Image size 2352x1568: 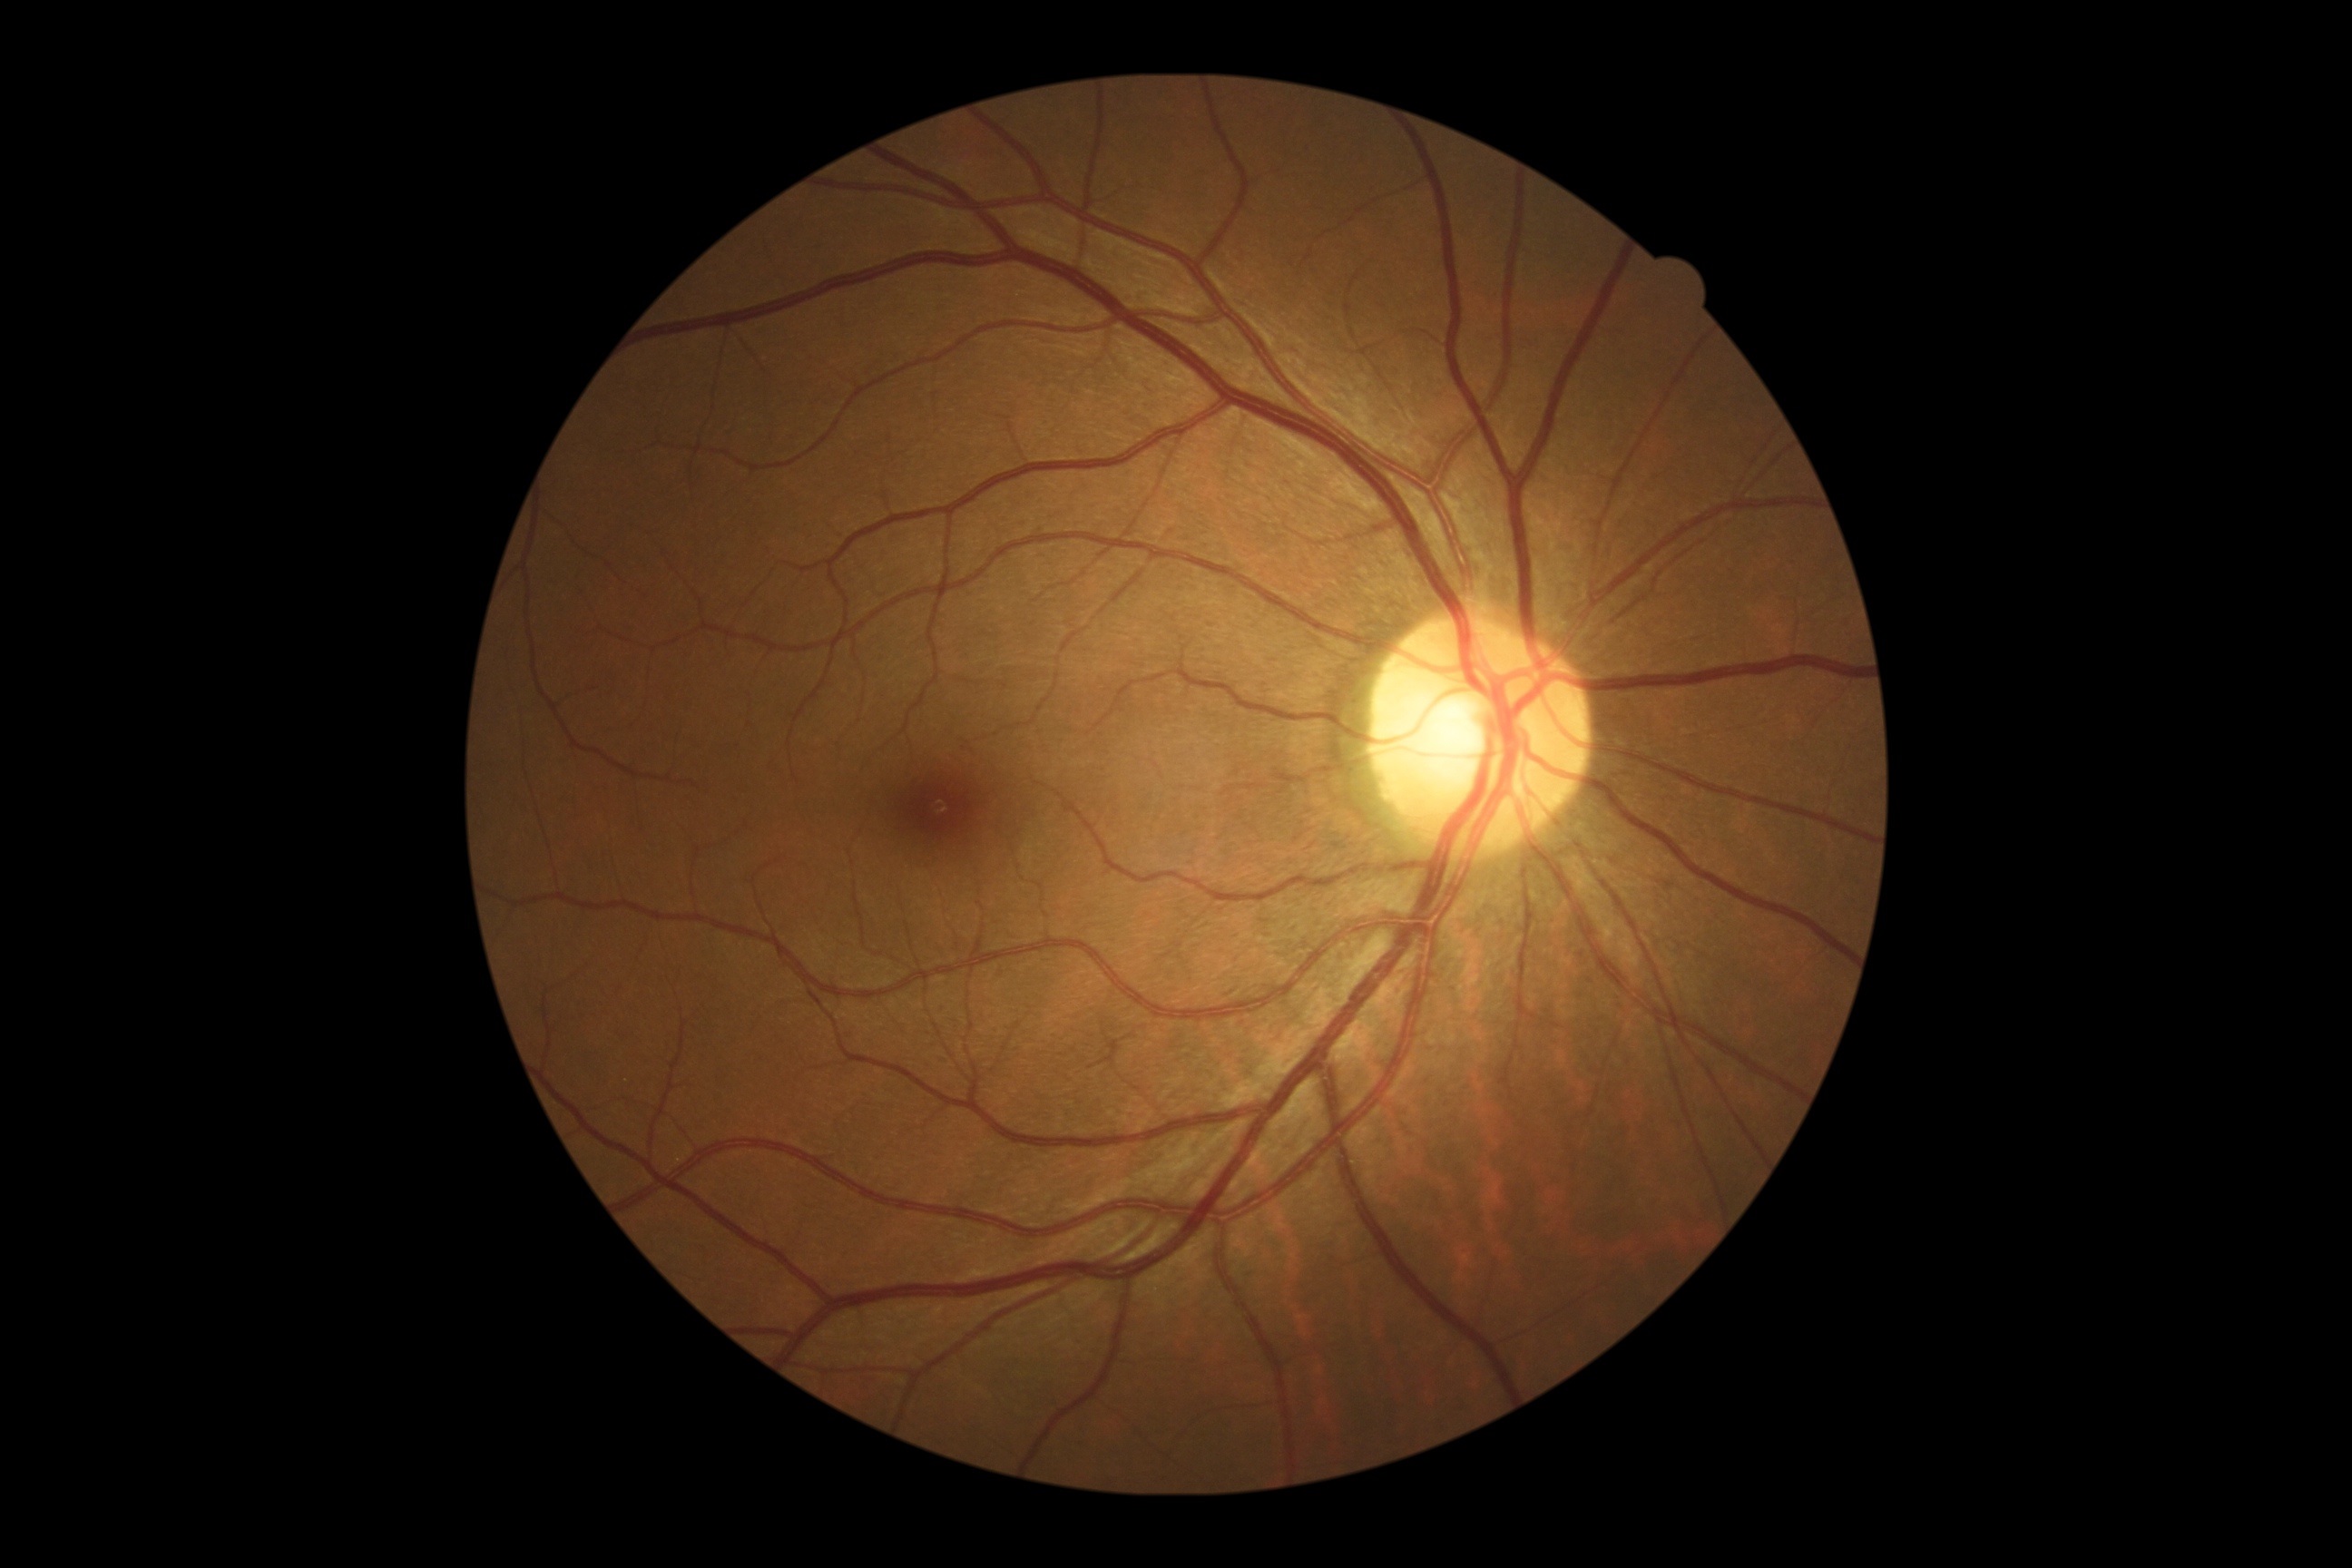

No apparent diabetic retinopathy.
DR severity is no apparent retinopathy (grade 0).